Wide-field contact fundus photograph of an infant:
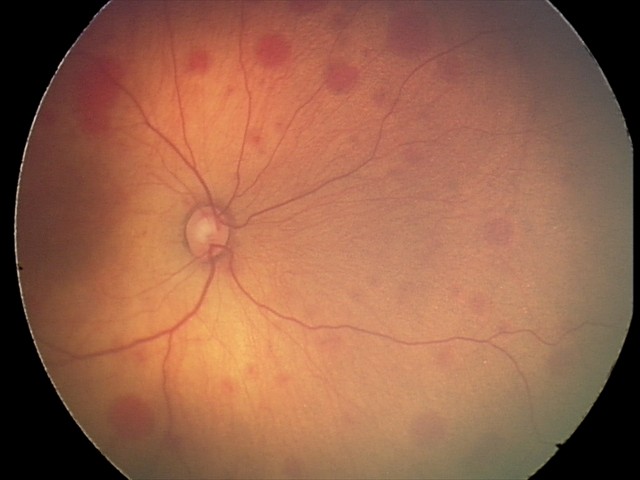

Examination diagnosed as retinal hemorrhages.